Image size 2352x1568 · CFP · 45-degree field of view.
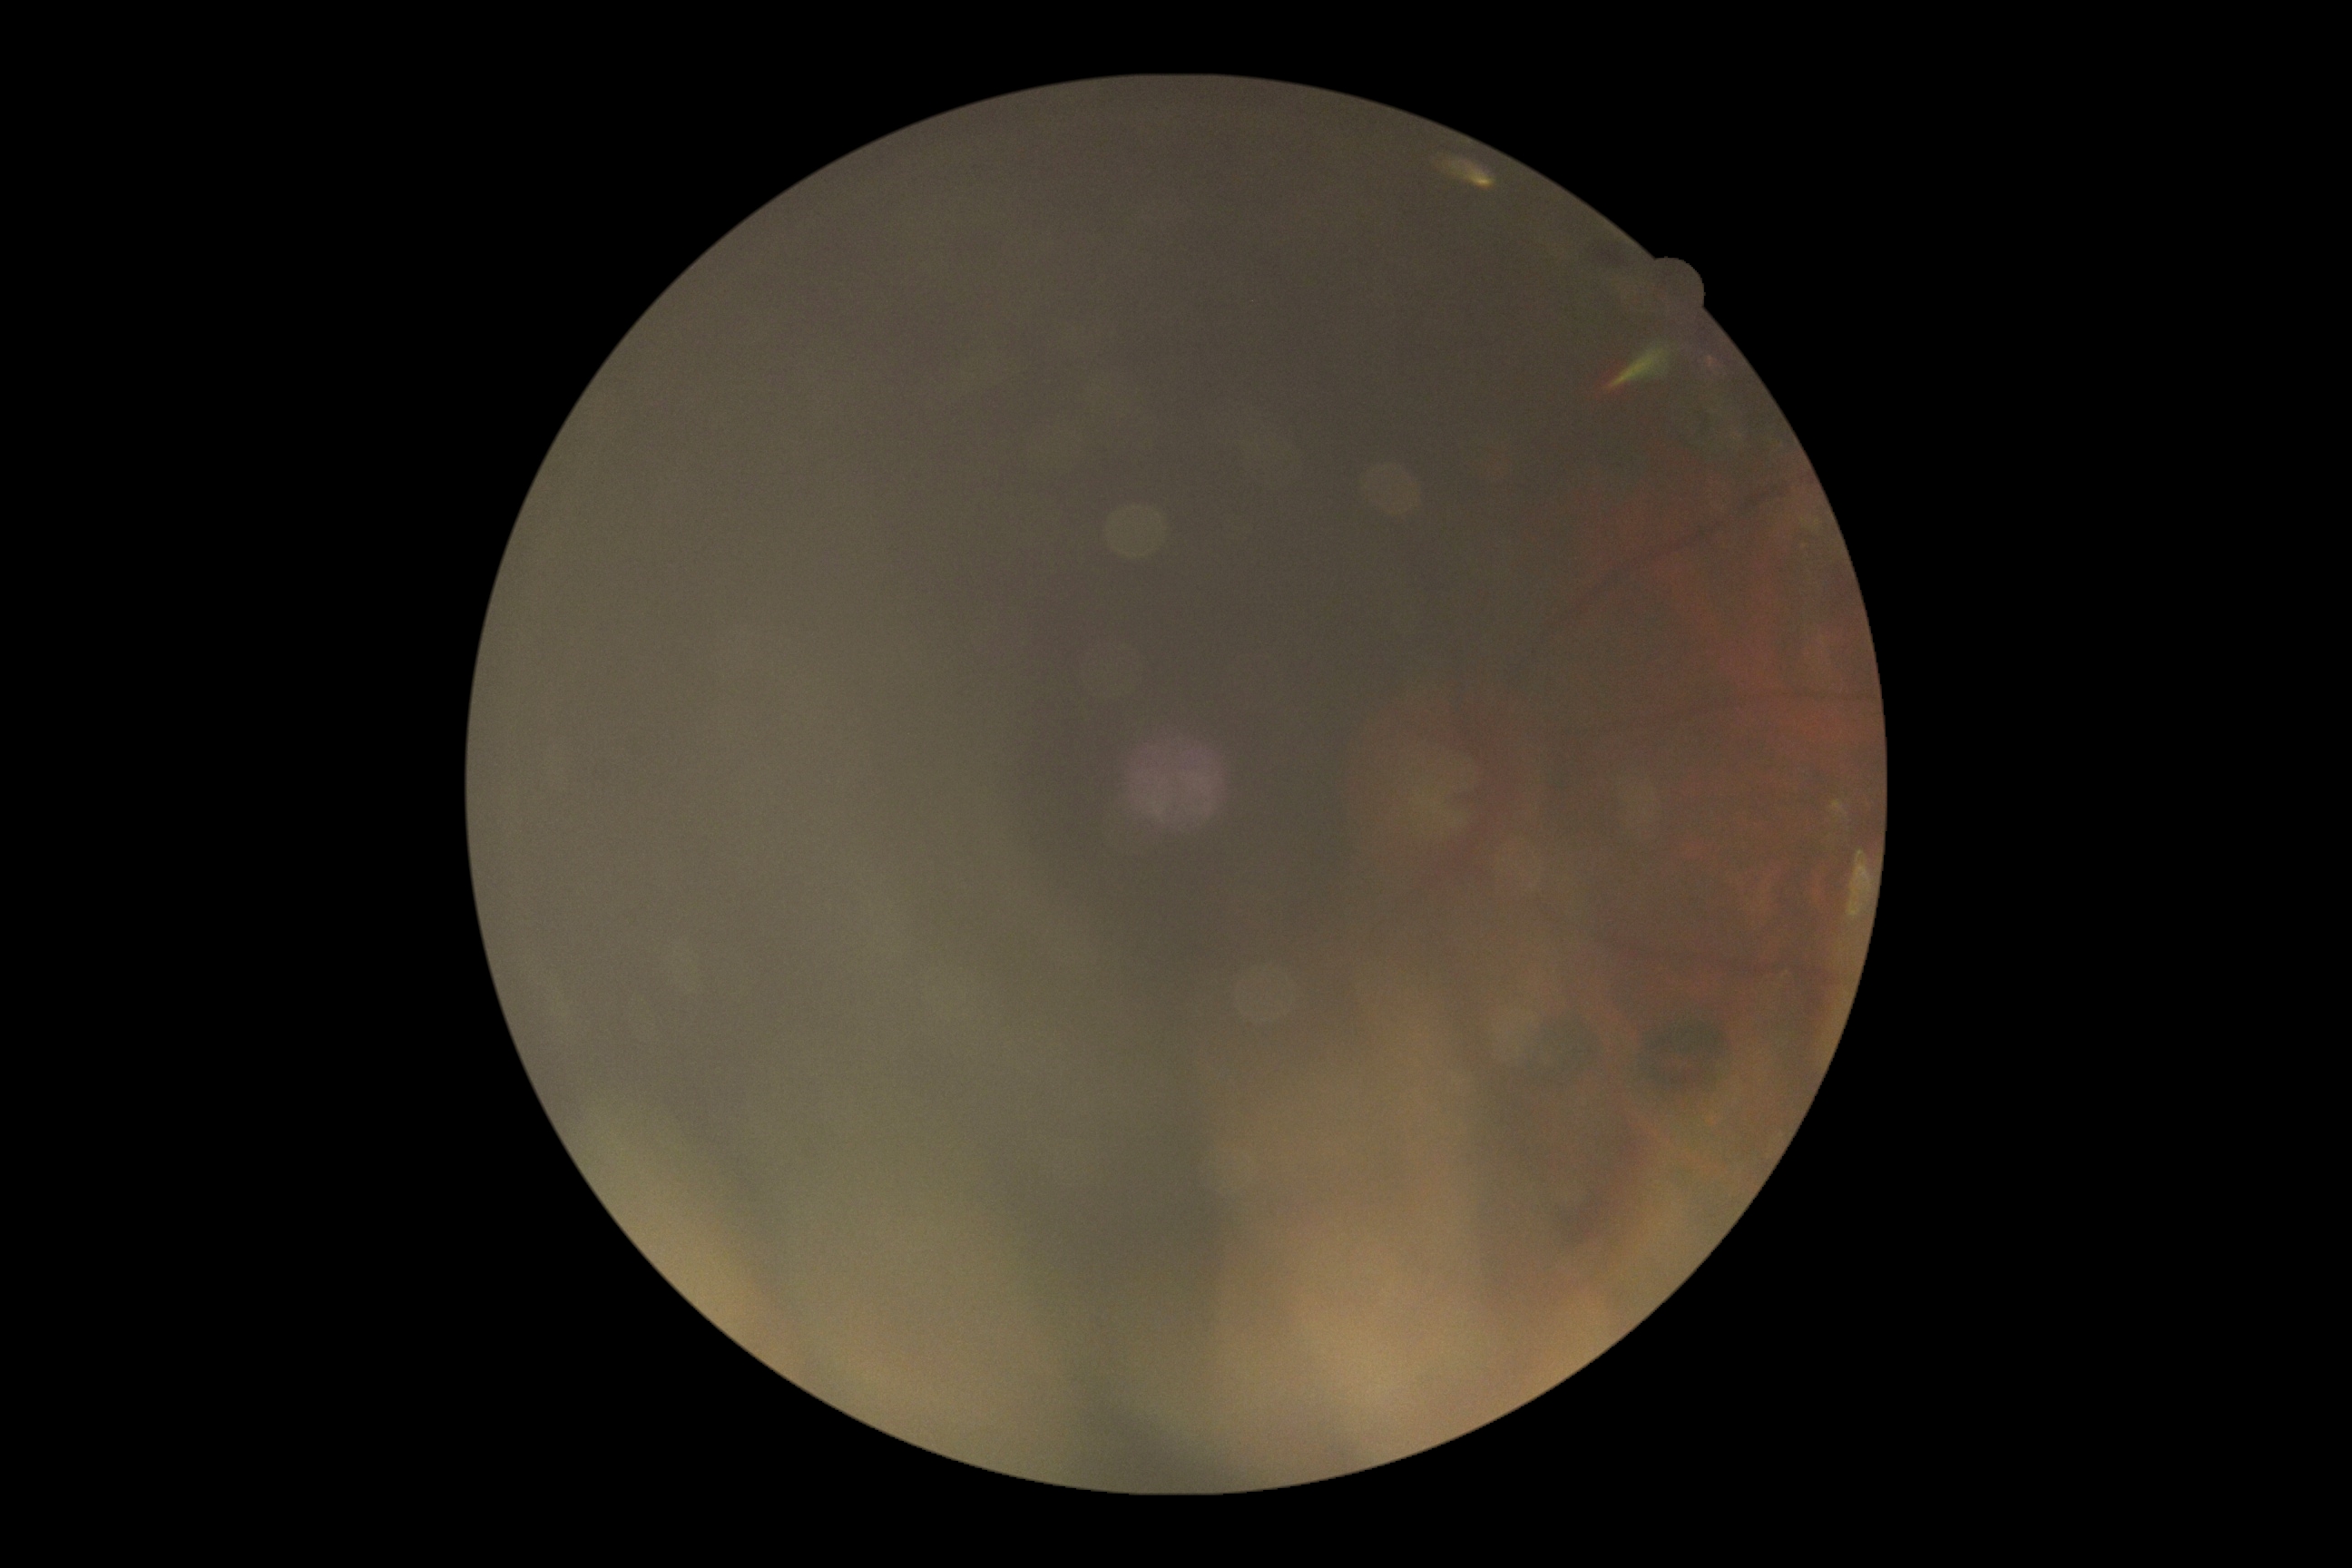 DR grade: ungradable.